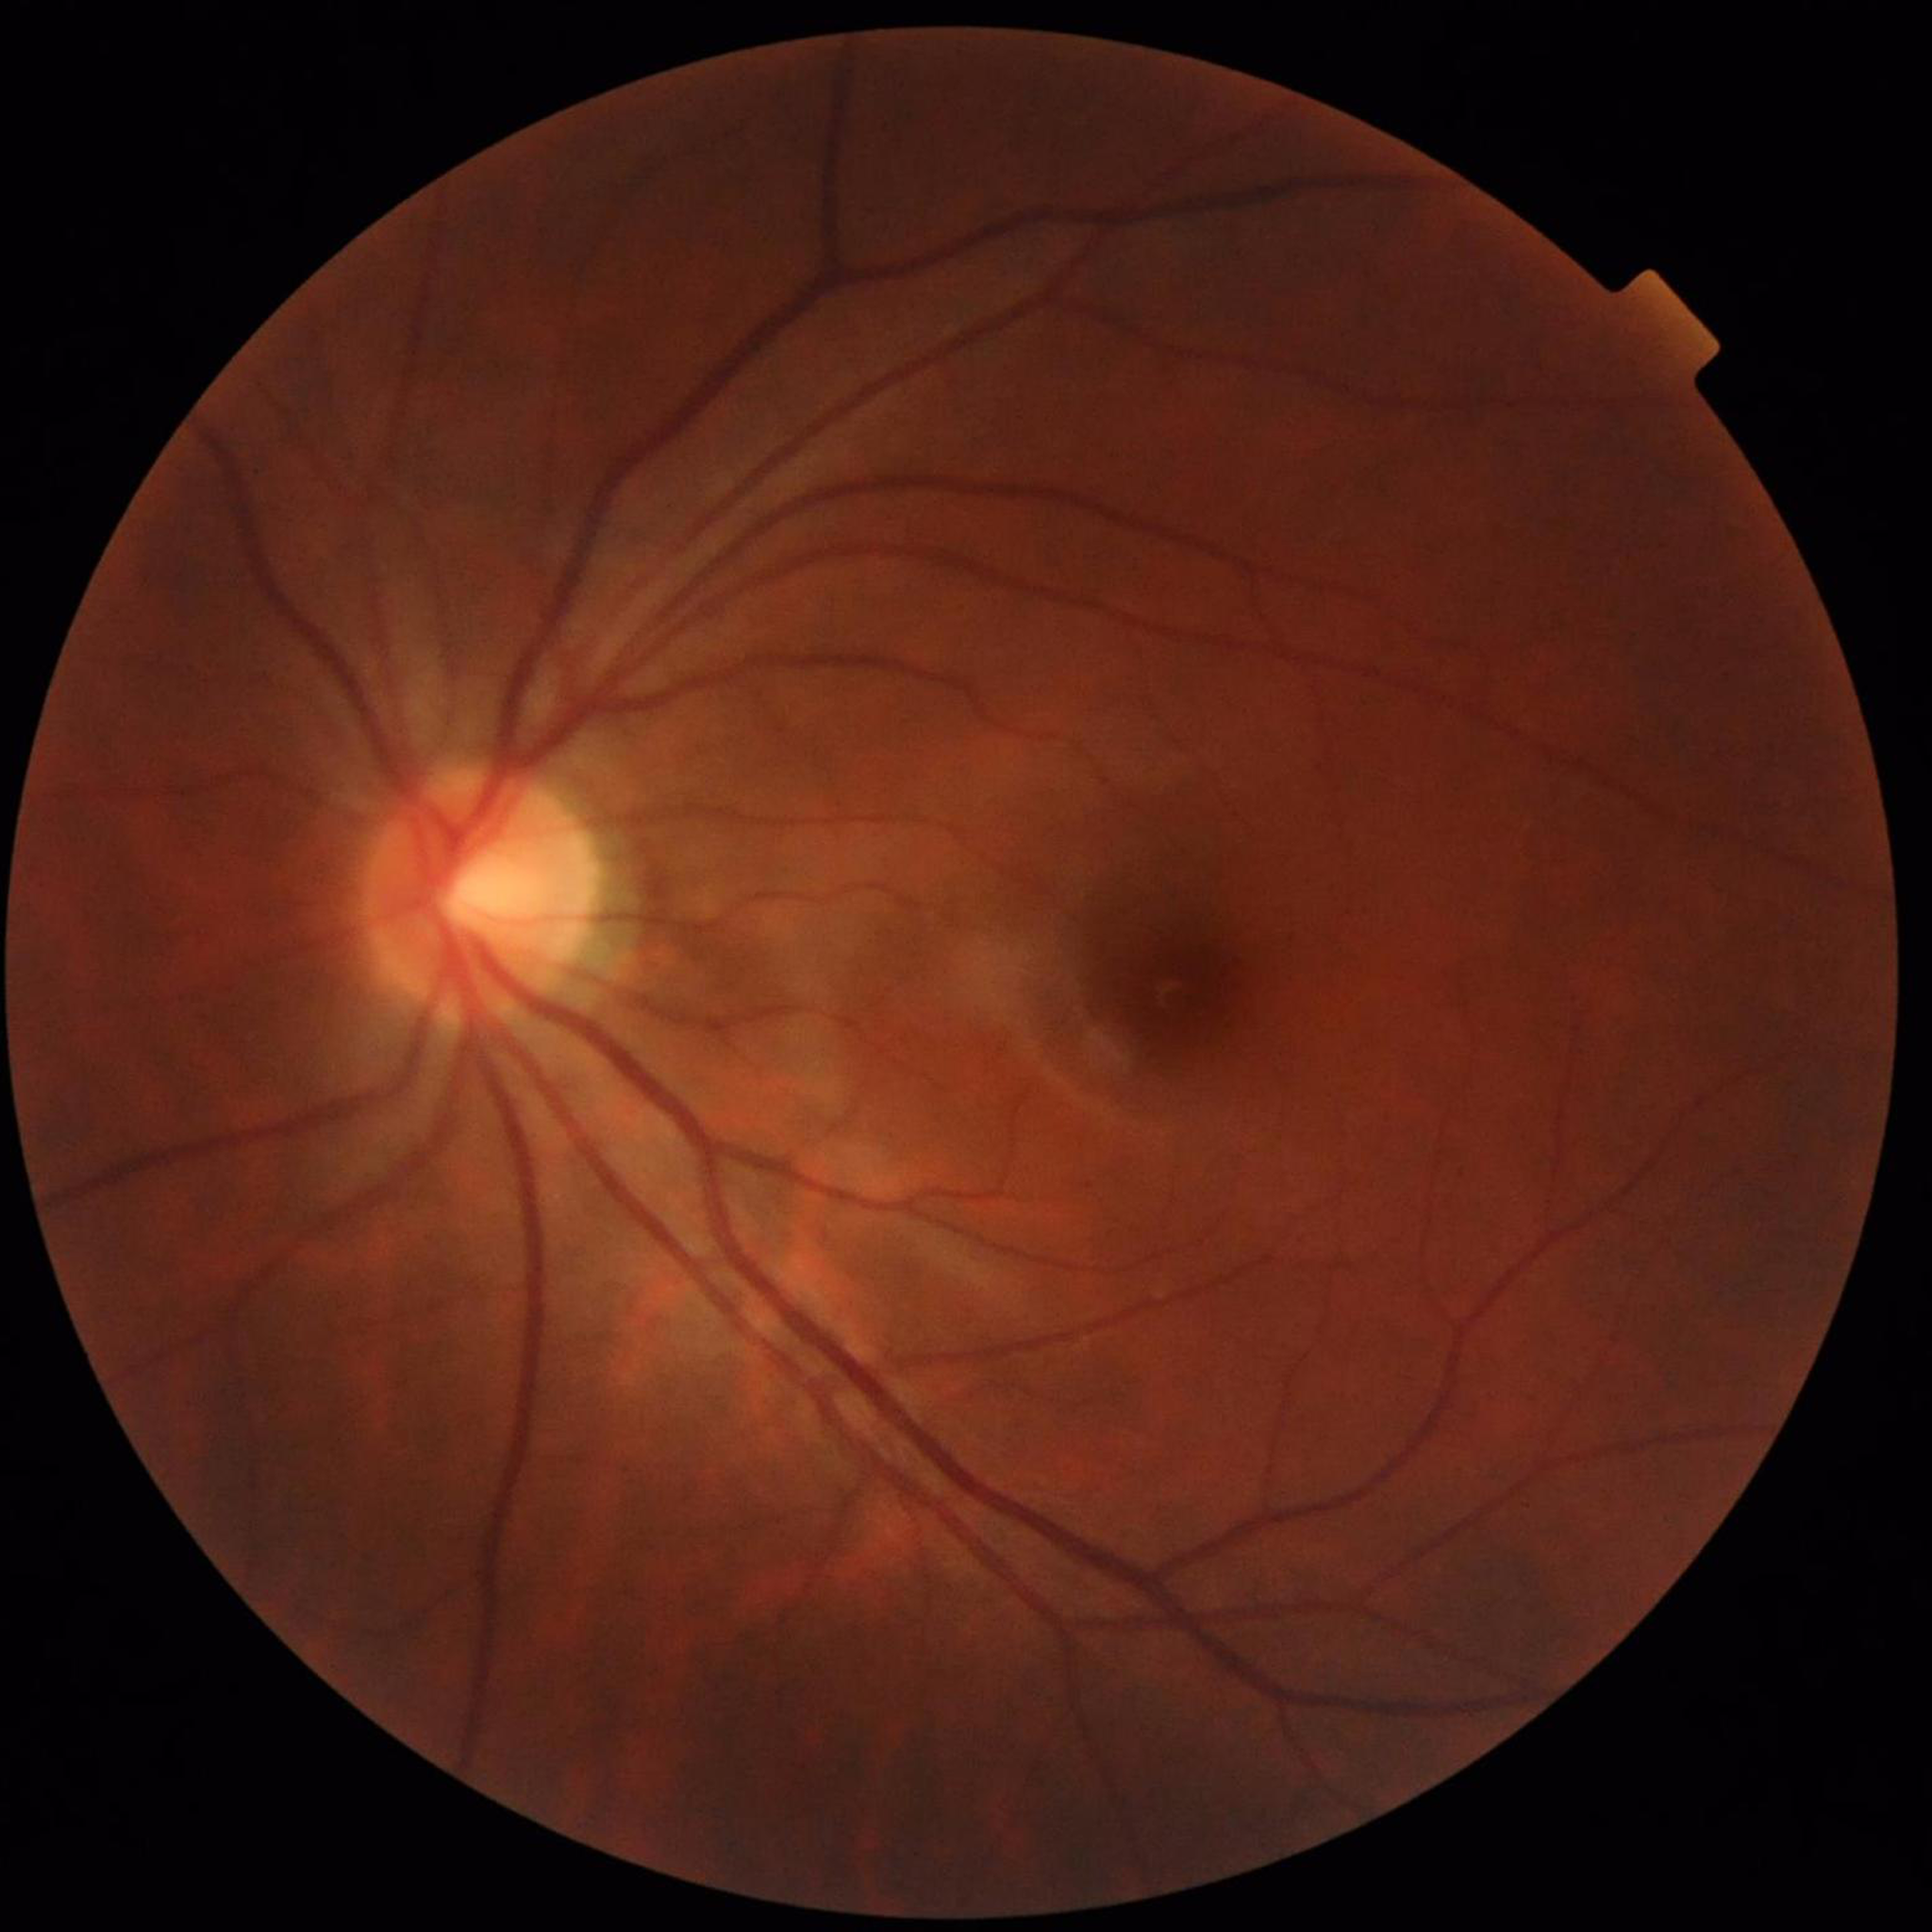

Control patient without diagnosed AMD, DR, or glaucoma.